Modified Davis grading:
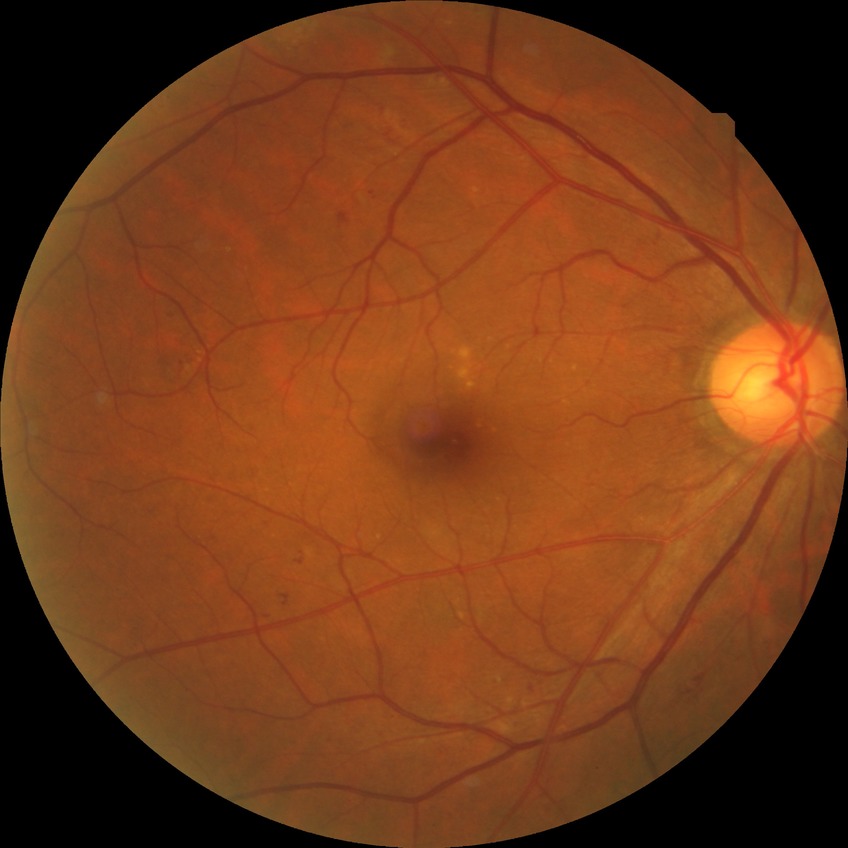

Diabetic retinopathy (DR) is SDR (simple diabetic retinopathy).